Graded on the modified Davis scale — 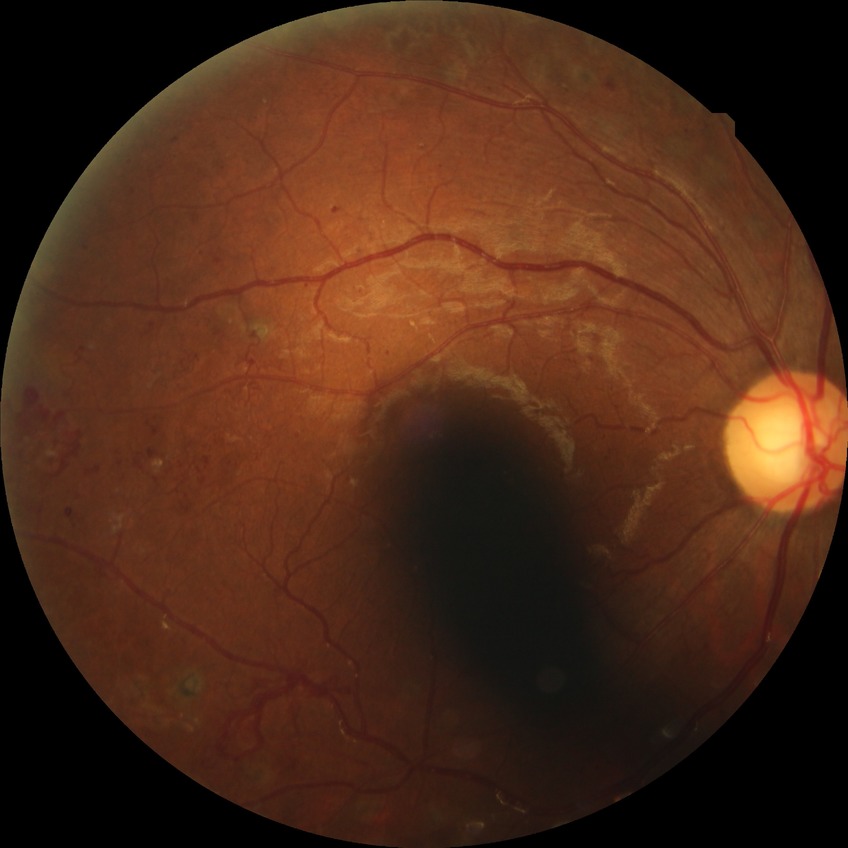
Diabetic retinopathy (DR) is proliferative diabetic retinopathy (PDR).